Infant wide-field fundus photograph — 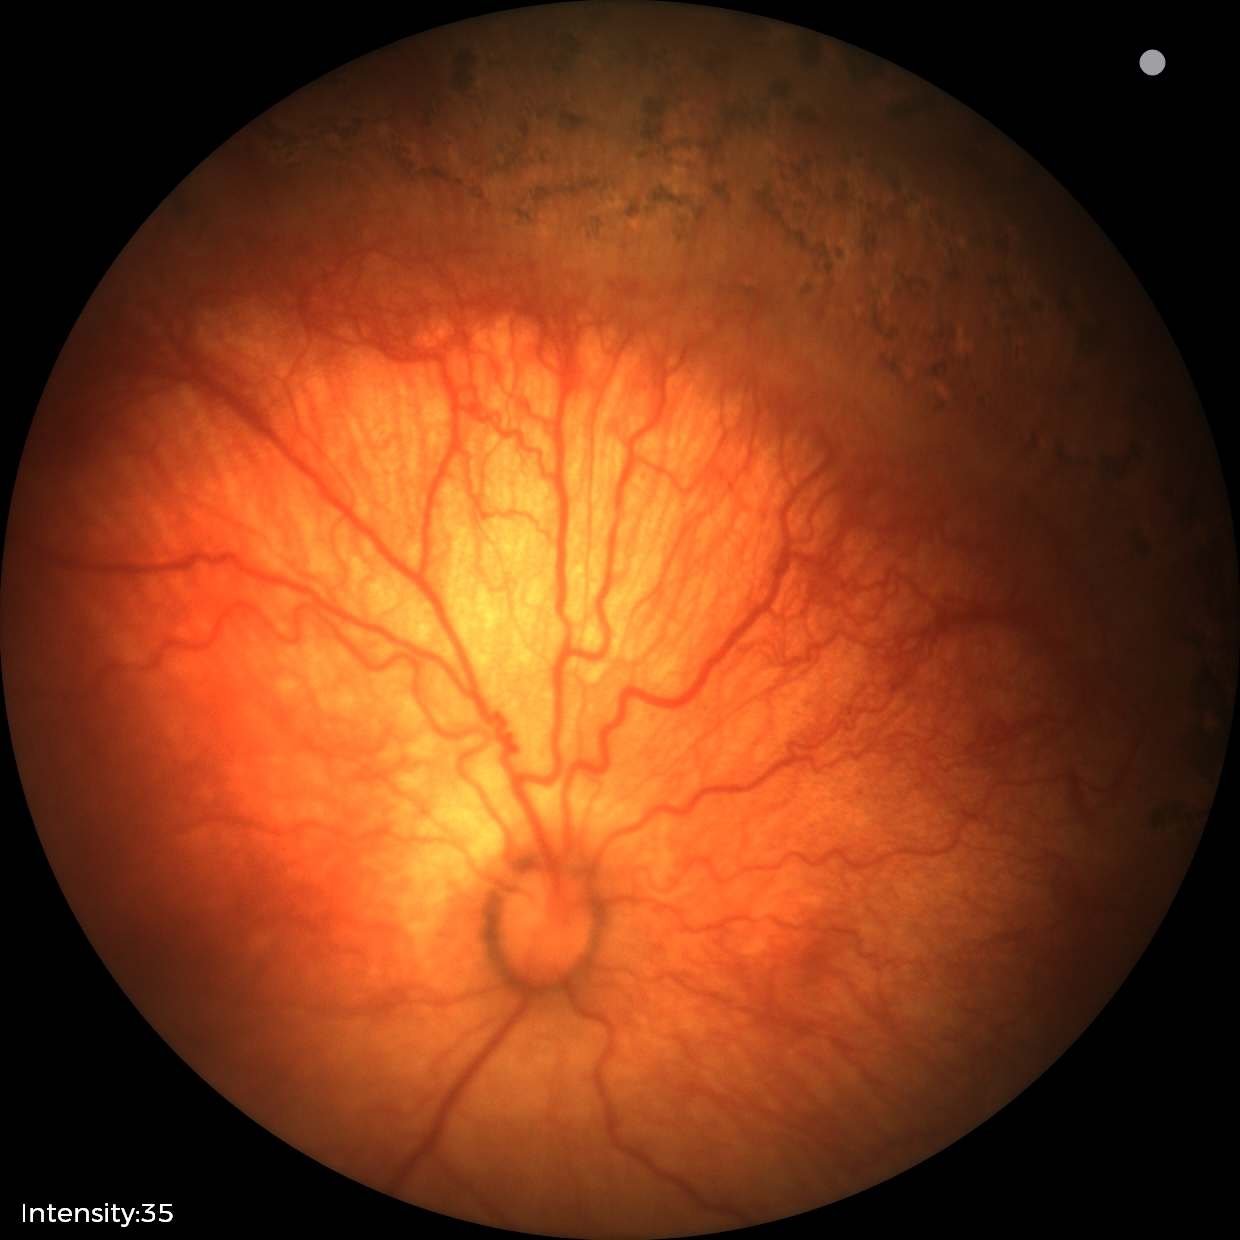

Finding: retinopathy of prematurity stage 1 — demarcation line between vascular and avascular retina.